Retinal fundus photograph; 2048x1536; FOV: 45 degrees:
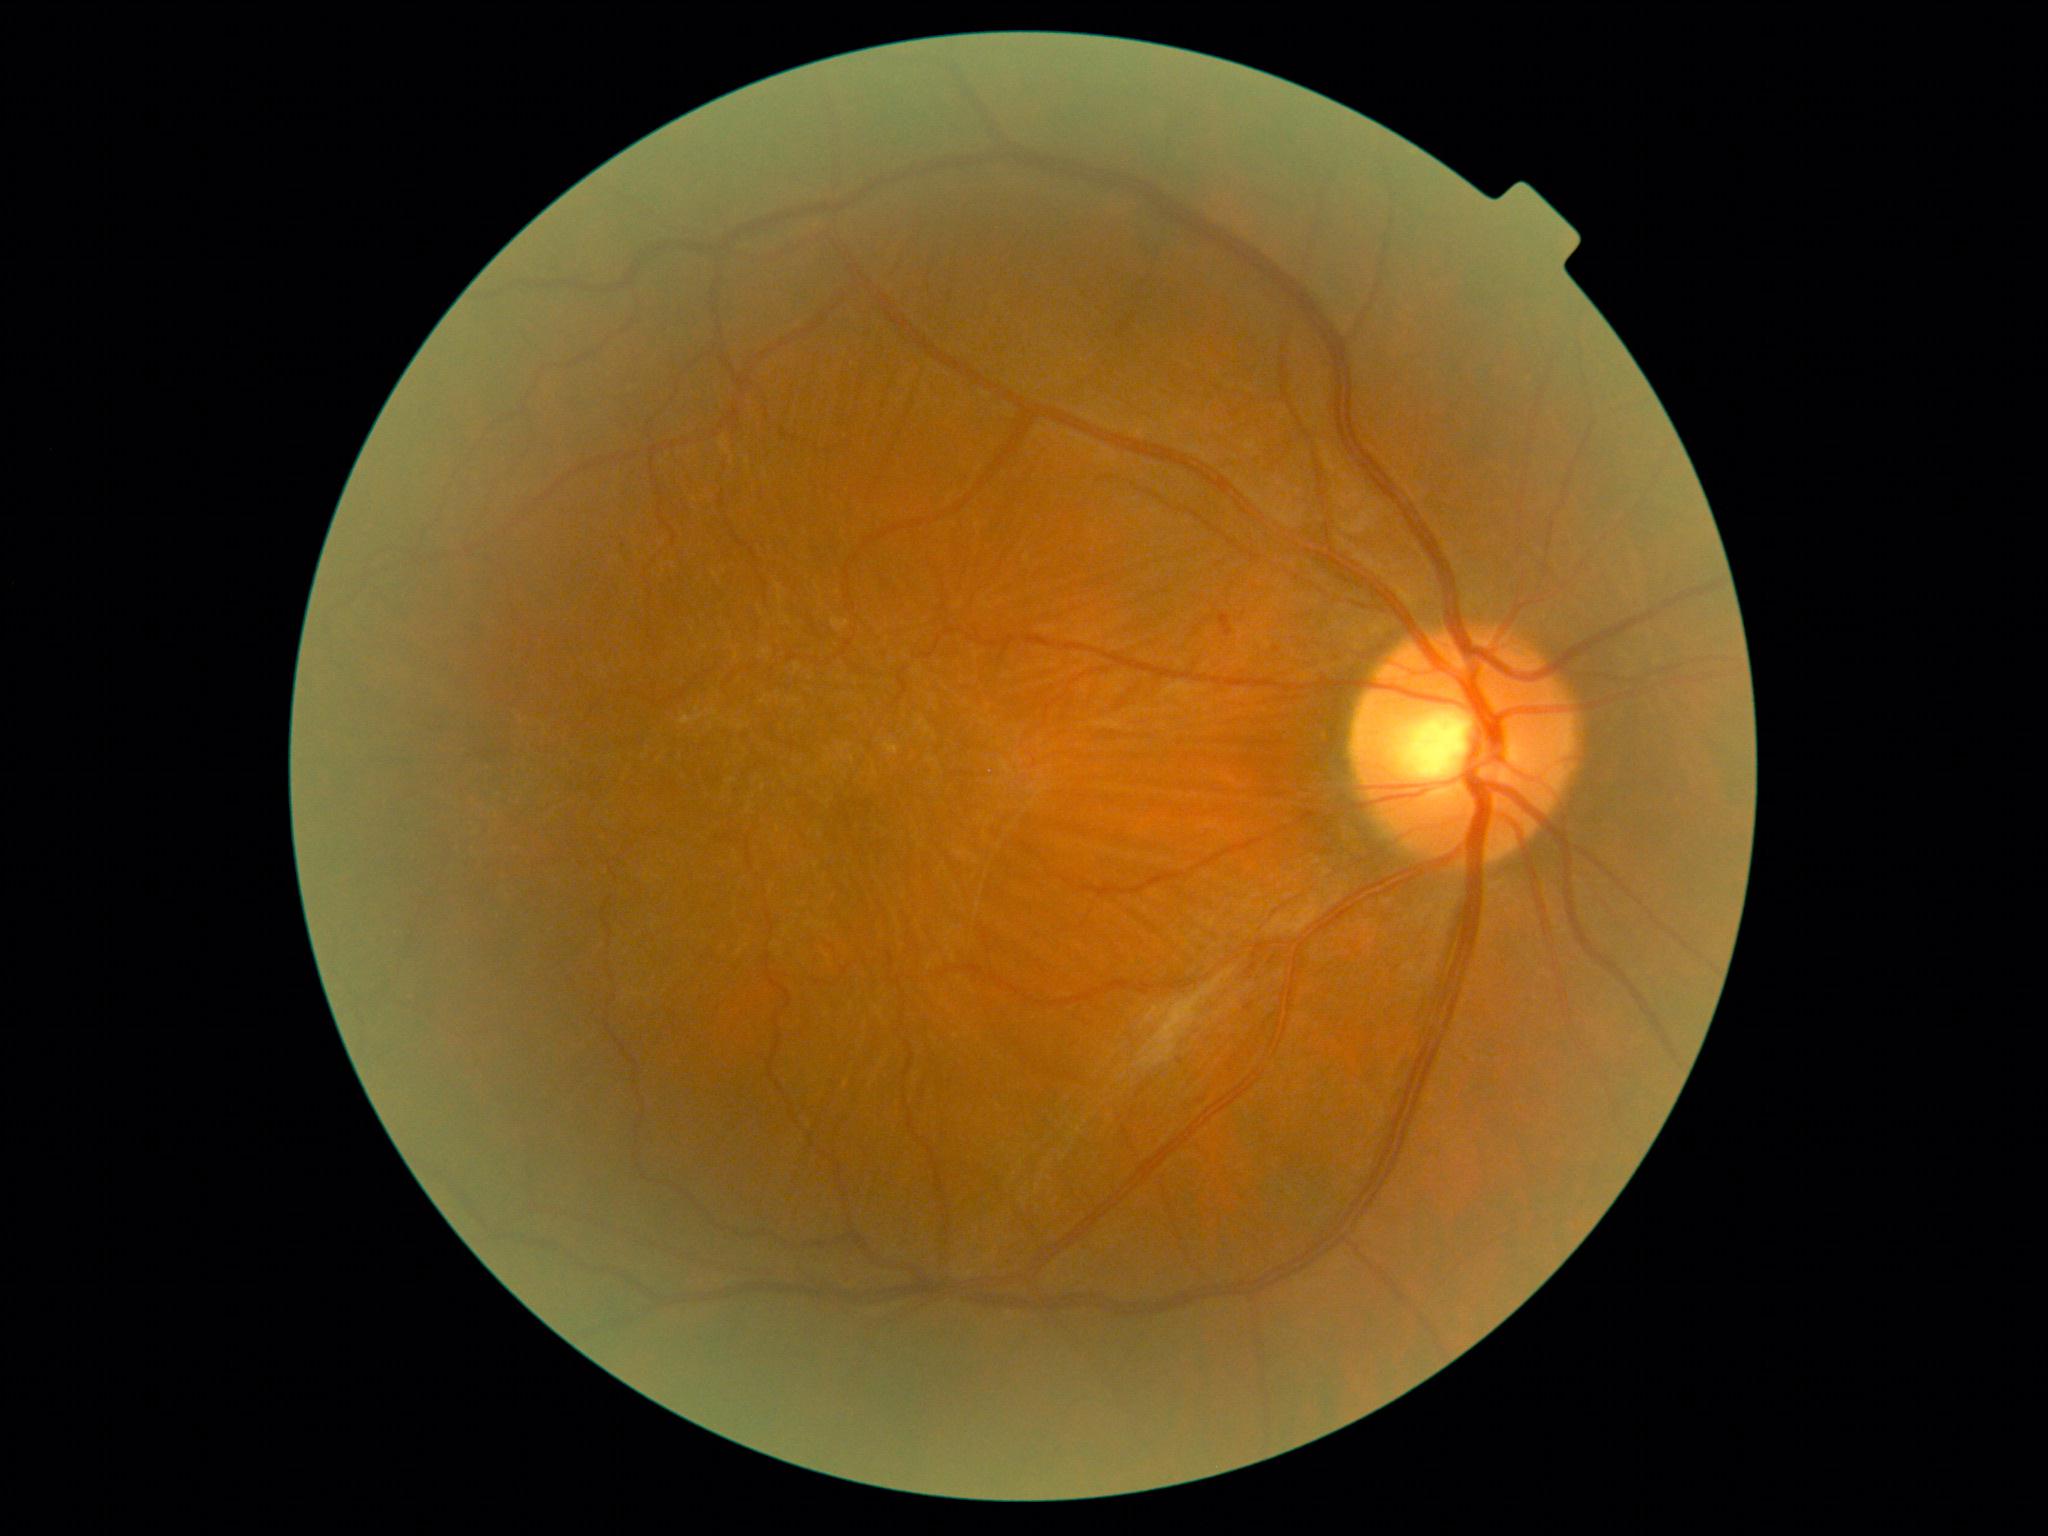 DR stage is mild non-proliferative diabetic retinopathy (grade 1).